Captured on a Nidek AFC-330 fundus camera:
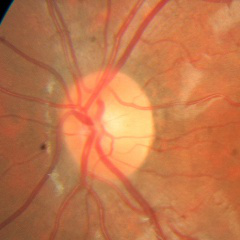 Q: What stage of glaucoma is present?
A: No — no evidence of glaucoma.